DR severity per modified Davis staging — 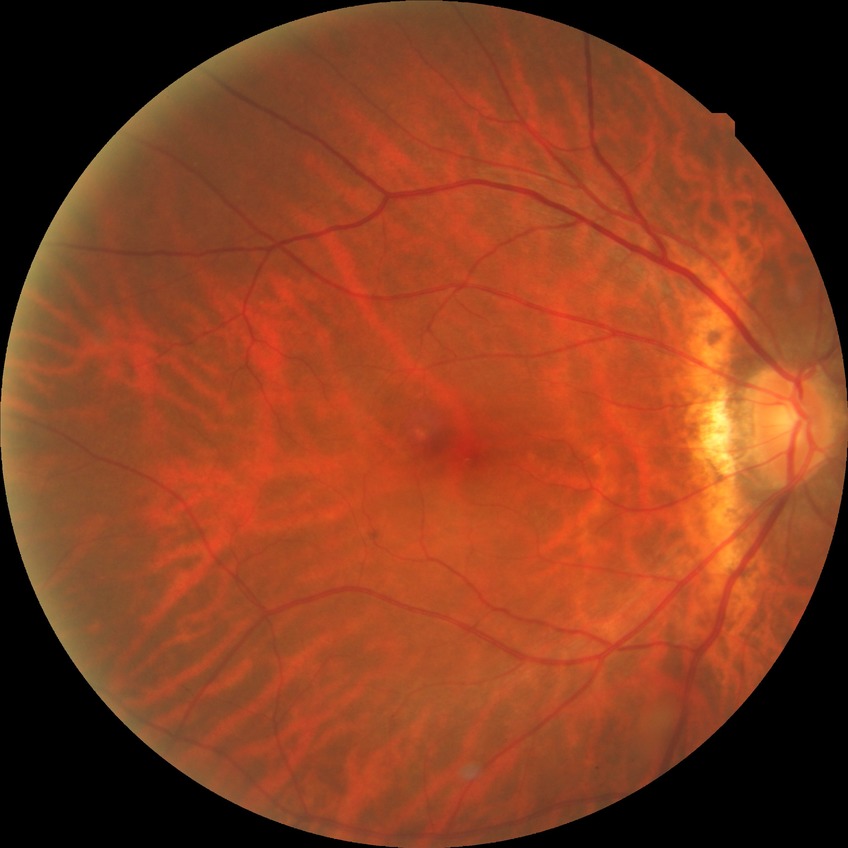 retinopathy grade: no diabetic retinopathy.